2048x1536px. Color fundus photograph: 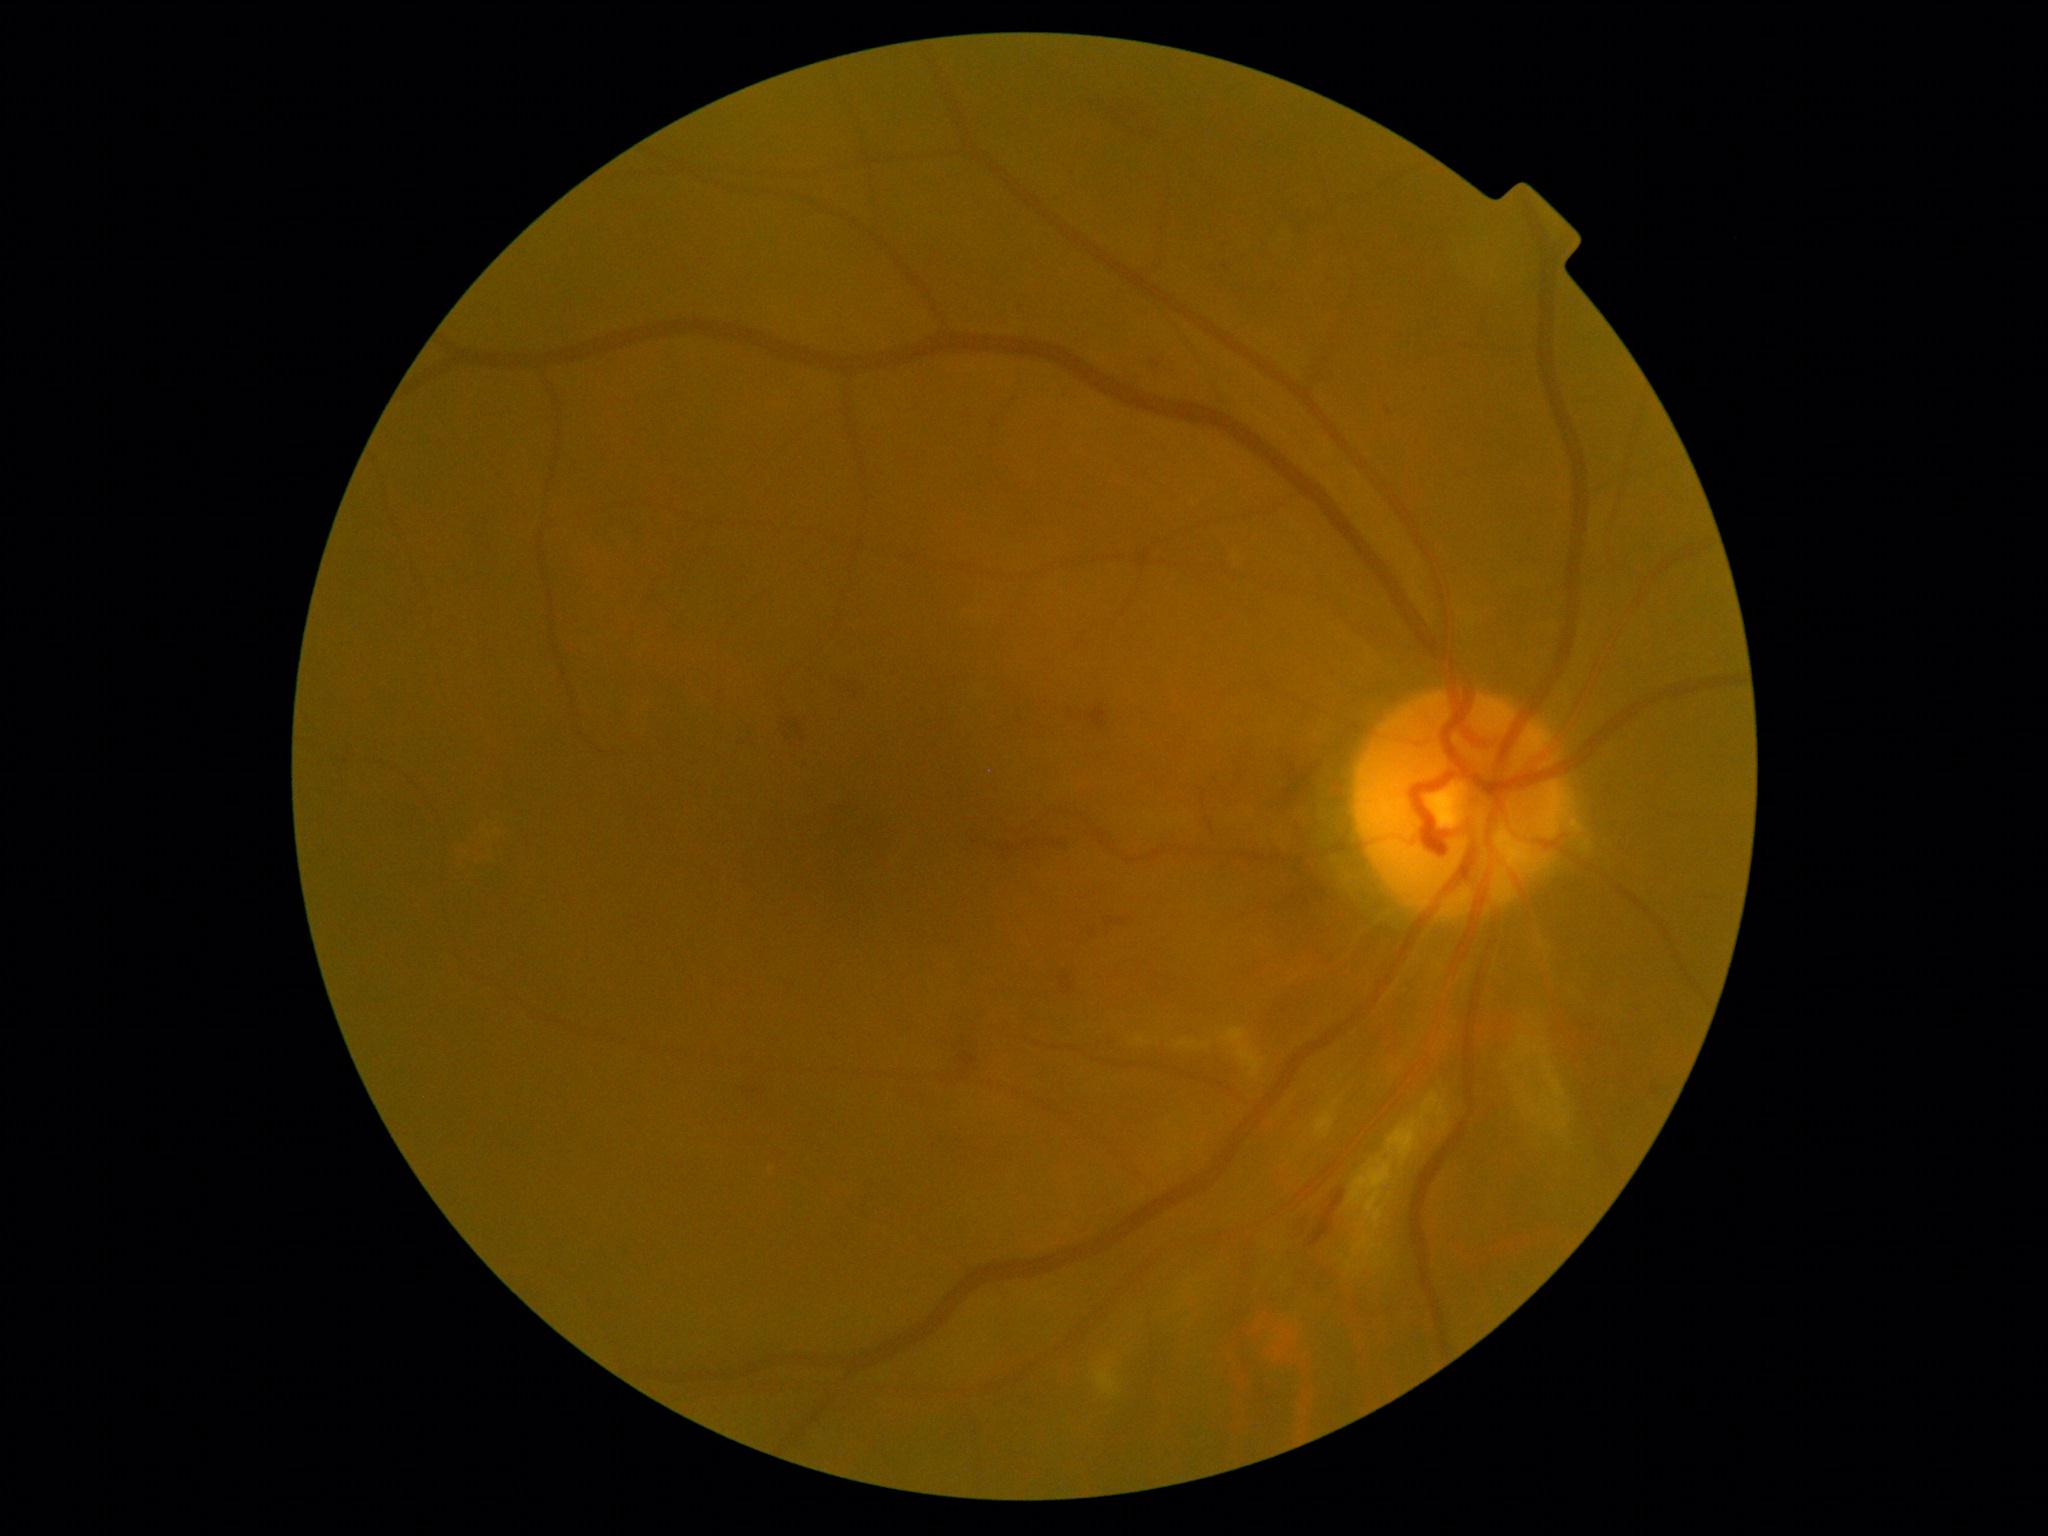

DR: moderate non-proliferative diabetic retinopathy (grade 2).